848 by 848 pixels — 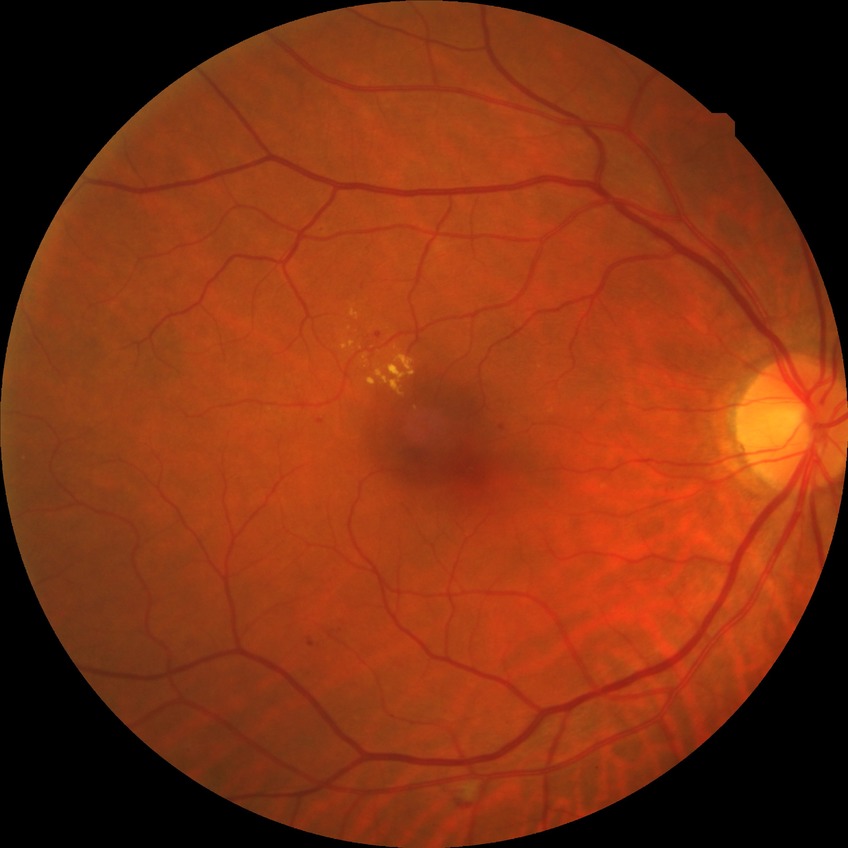
Davis DR grade = SDR.